Posterior pole color fundus photograph: 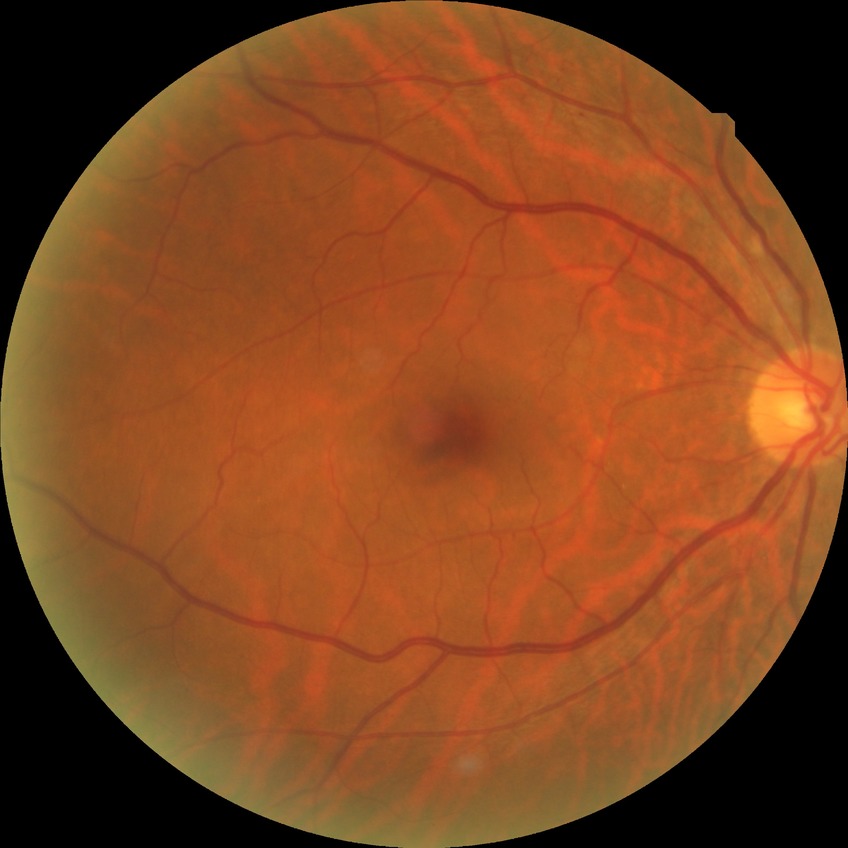

DR severity = SDR.